Camera: Nidek AFC-330. 240x240px
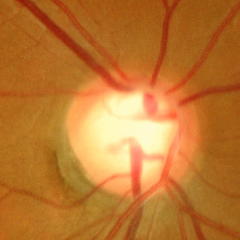

Color fundus photograph showing severe glaucomatous damage.